45° FOV · CFP.
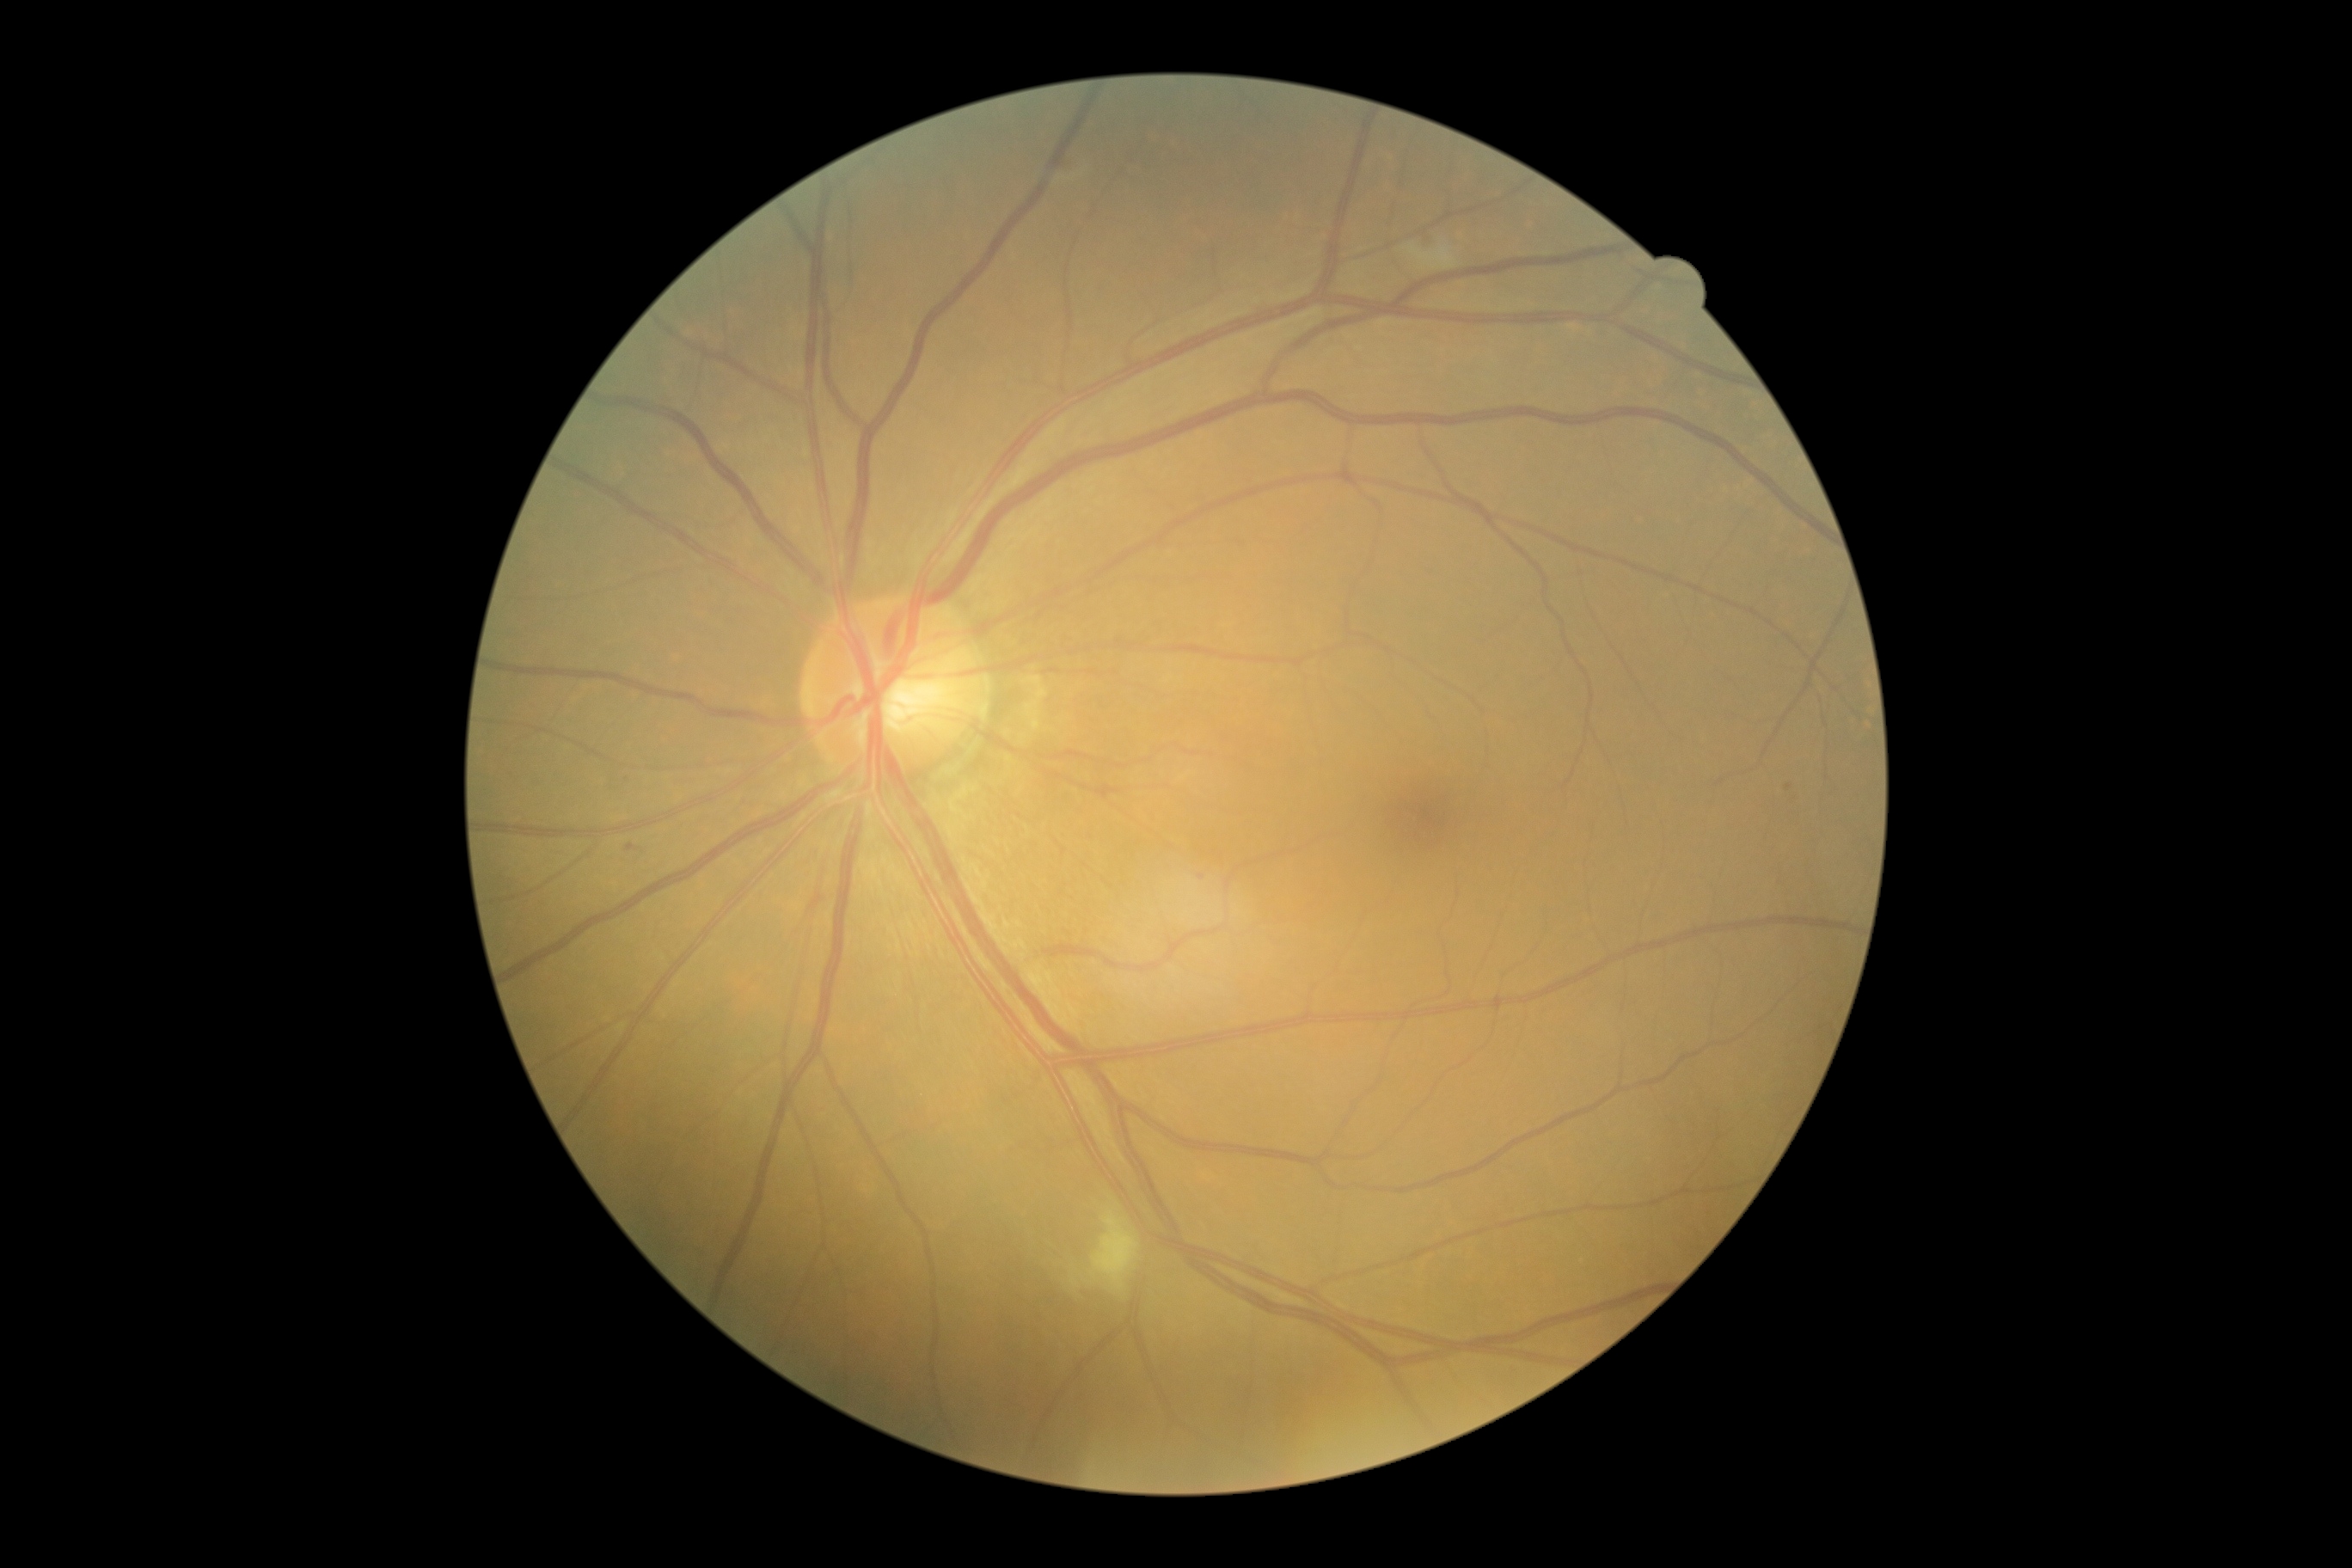
DR severity: grade 2 (moderate NPDR).